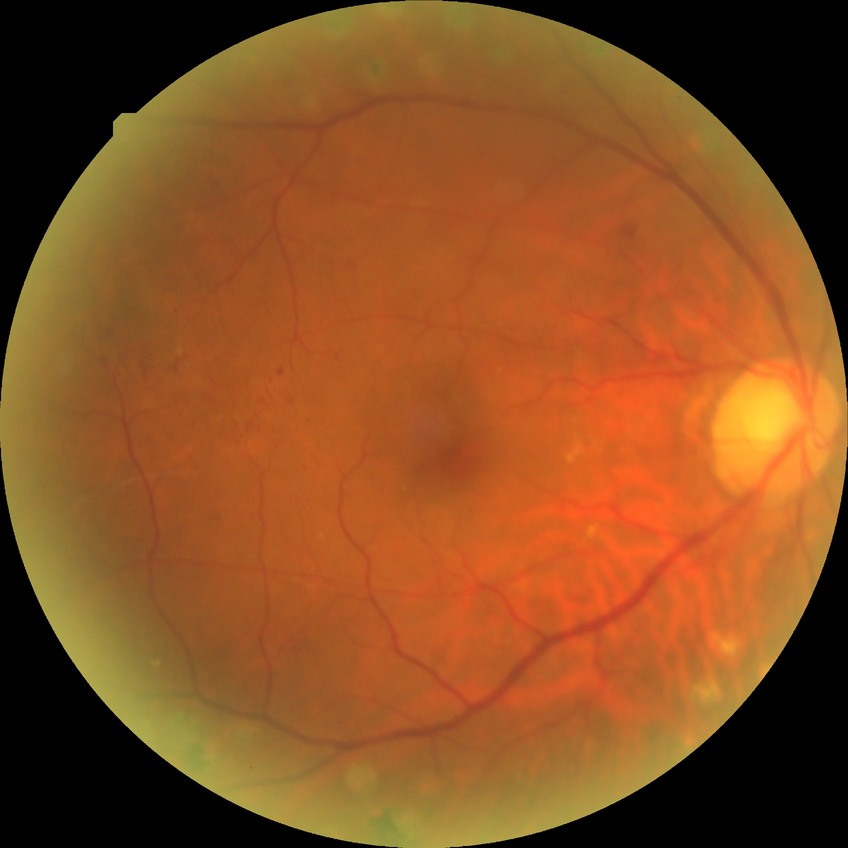
Assessment:
– diabetic retinopathy (DR) — PDR (proliferative diabetic retinopathy)